Optic nerve head crop; image size 240x240: 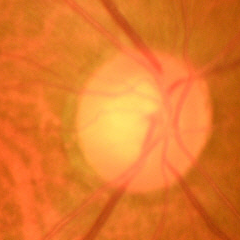
Findings consistent with no glaucomatous findings.